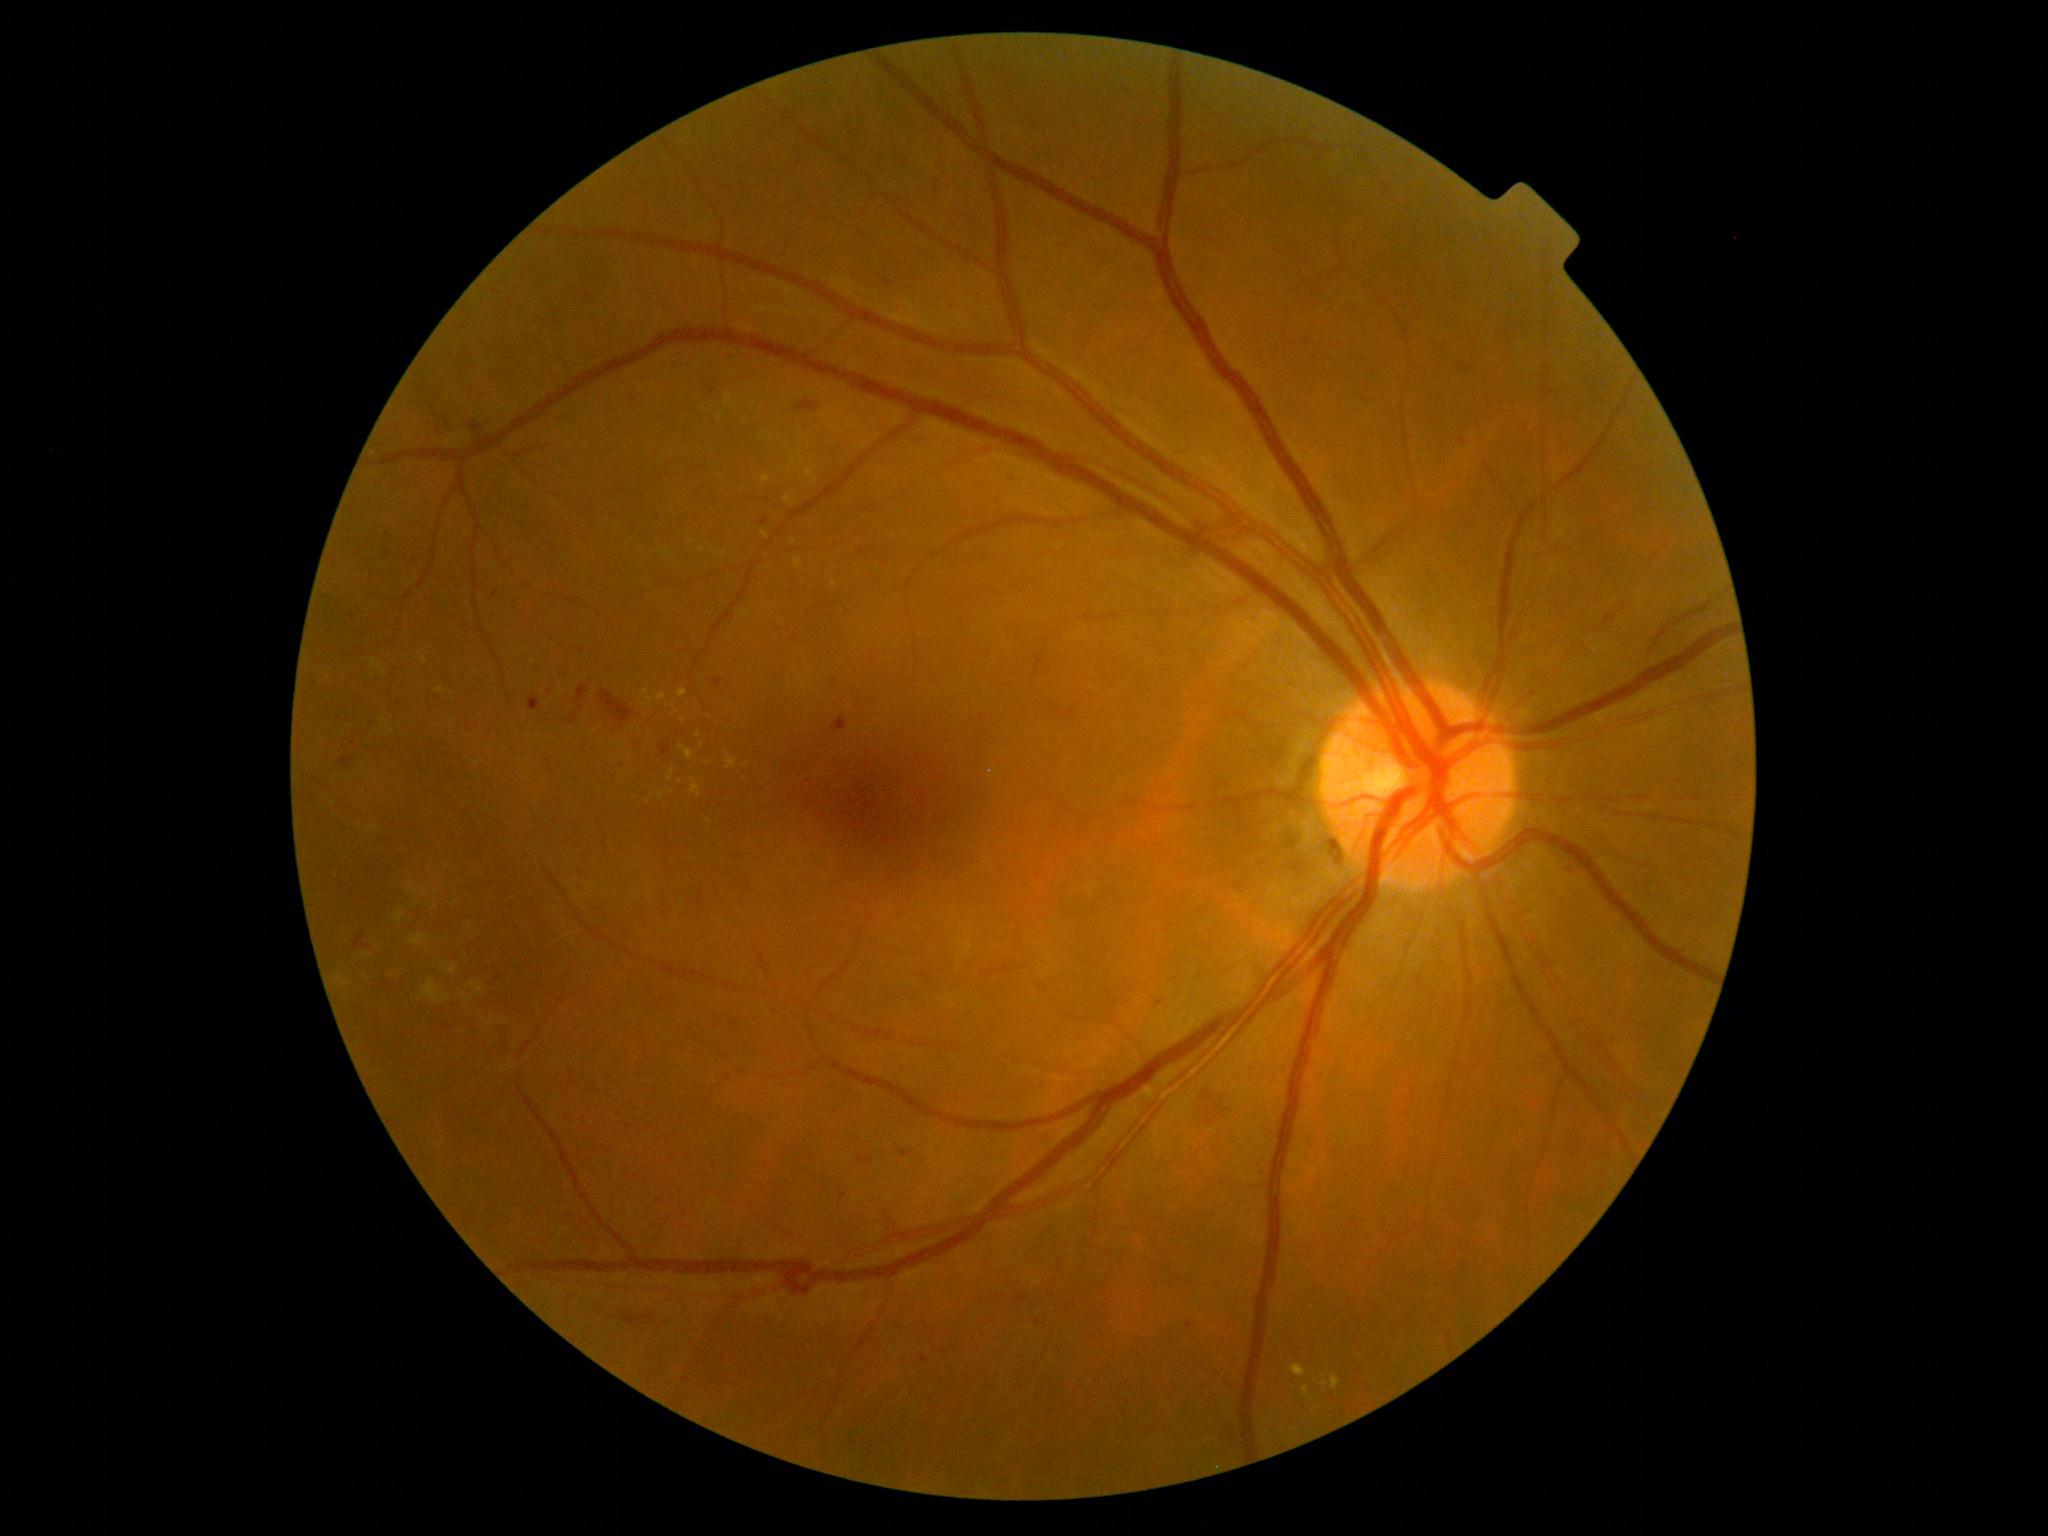

partial: true
dr_grade: 2
dr_grade_name: moderate NPDR
lesions:
  ex:
    - 1302, 1386, 1311, 1398
    - 658, 693, 666, 702
    - 719, 553, 727, 557
    - 761, 530, 769, 540
    - 674, 707, 679, 715
    - 1292, 1365, 1307, 1377
    - 685, 750, 694, 759
    - 727, 757, 737, 770
    - 436, 687, 444, 693
    - 784, 495, 791, 504
  ex_small_approx:
    - point(683, 720)
    - point(701, 550)
    - point(794, 542)
    - point(800, 457)
    - point(991, 772)
    - point(683, 747)
    - point(650, 699)